1504 x 1000 pixels:
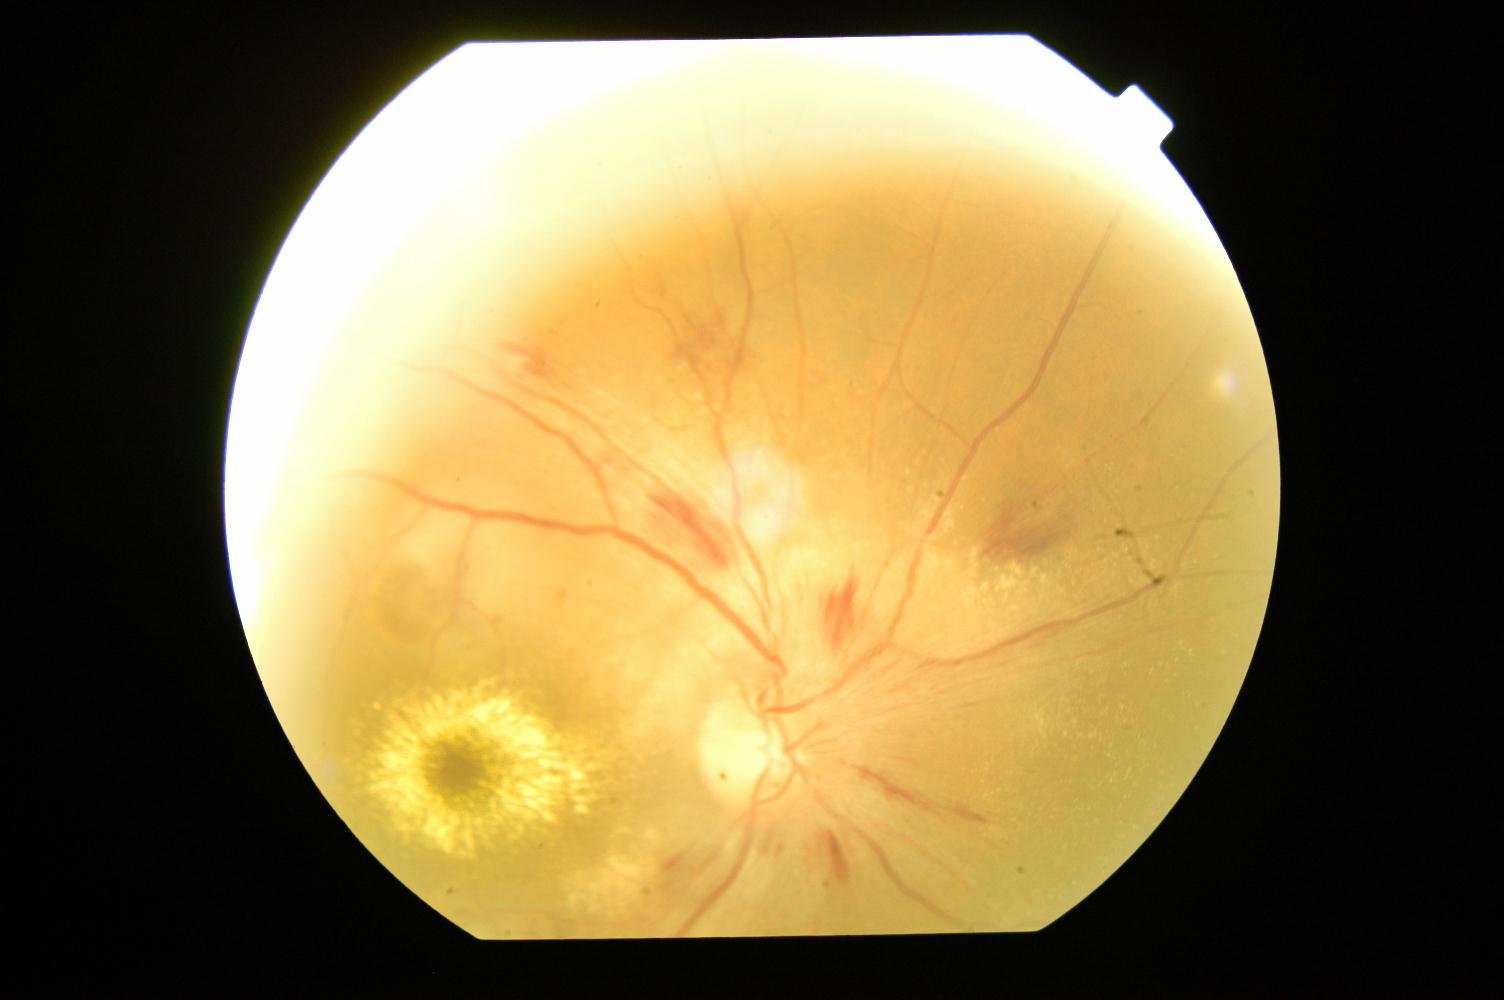

Fundus appearance consistent with hypertensive retinopathy.